FOV: 45 degrees.
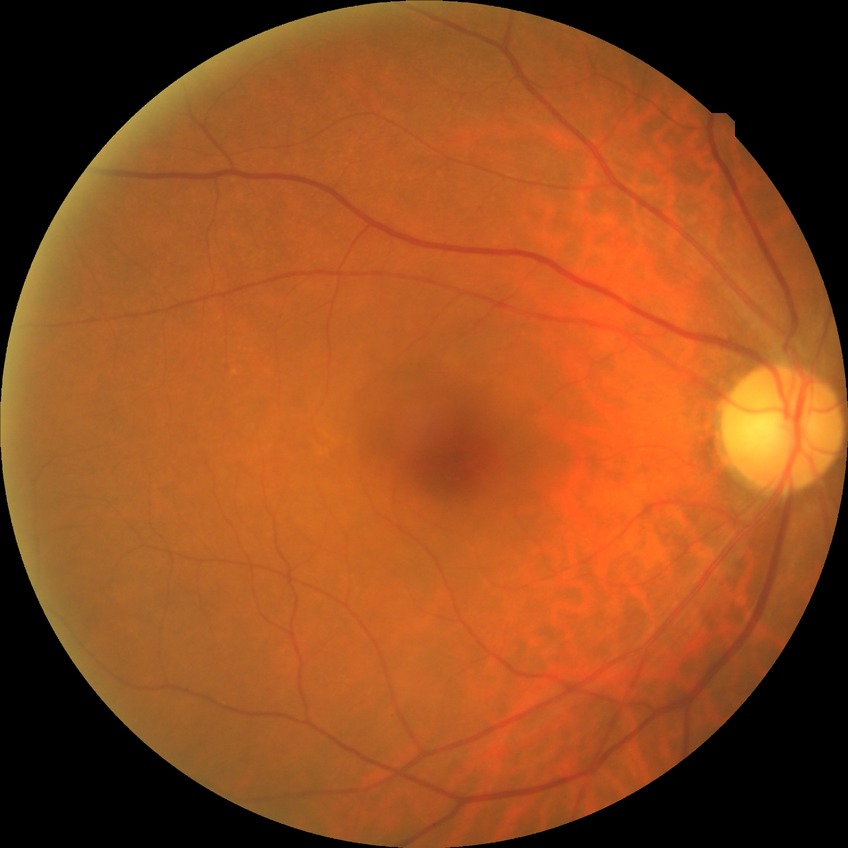 retinopathy grade: no diabetic retinopathy.